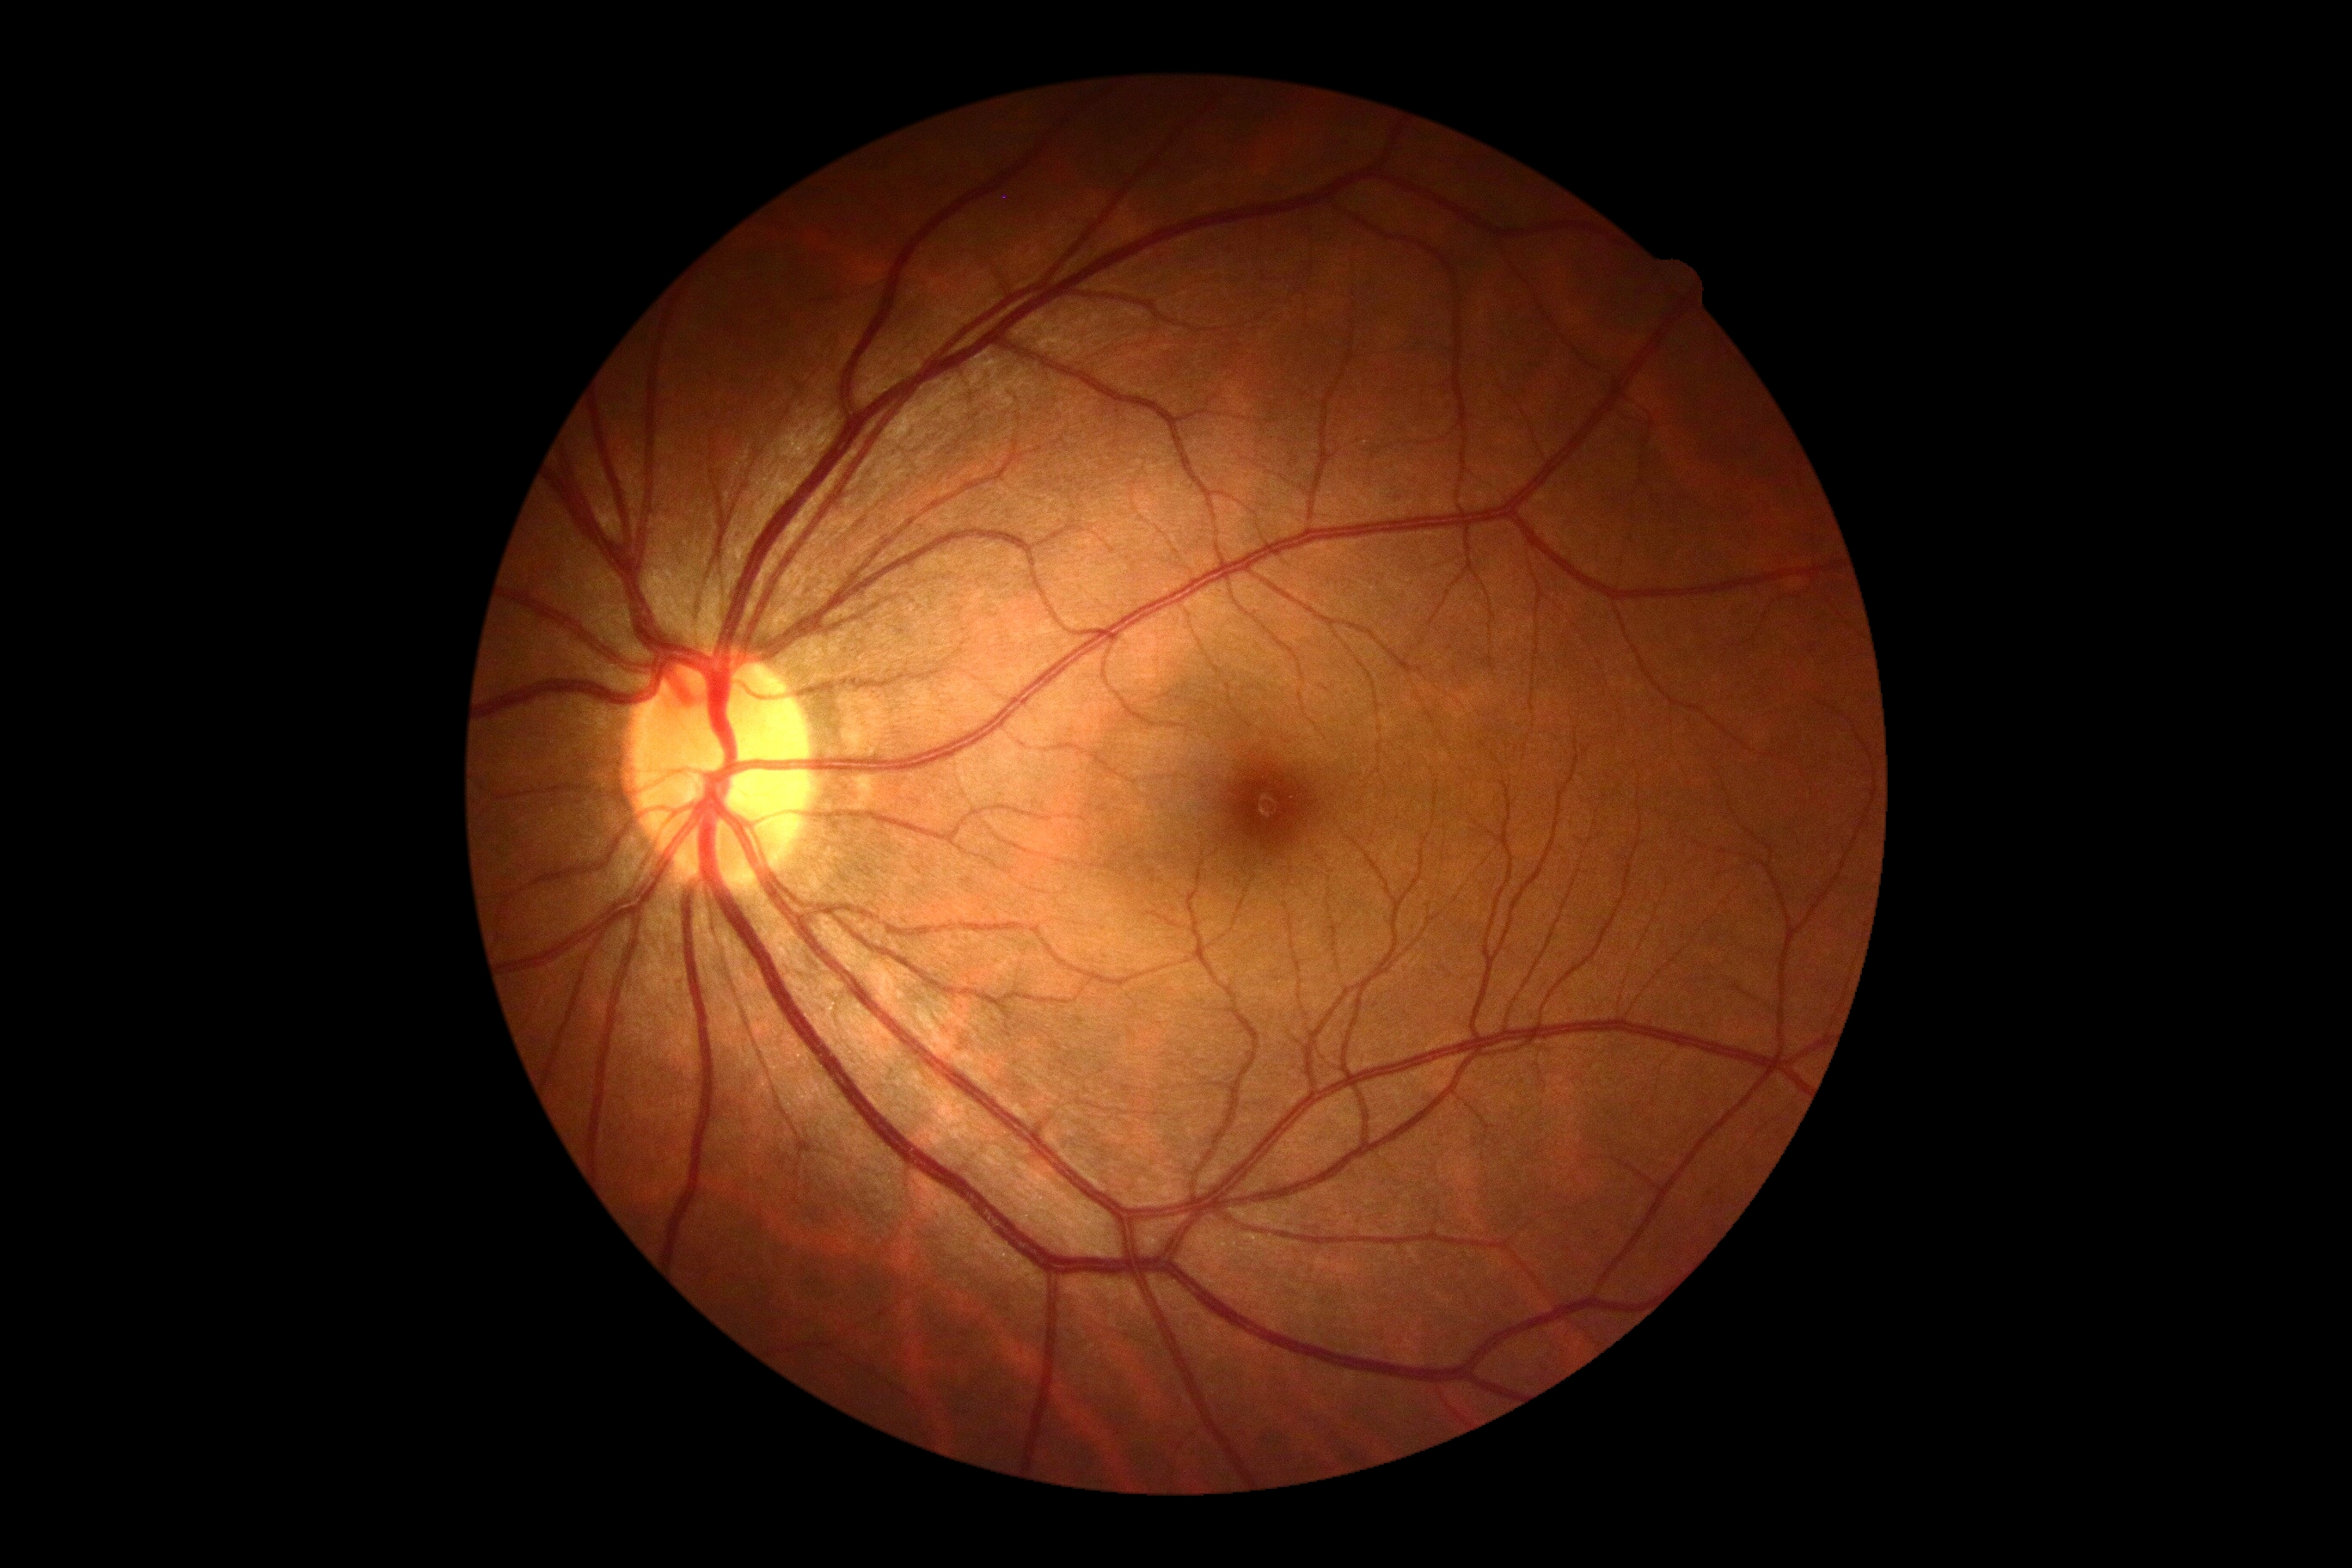

DR severity is no apparent diabetic retinopathy (grade 0). No DR findings.